Acquired on the Phoenix ICON · infant wide-field retinal image · 1240x1240px
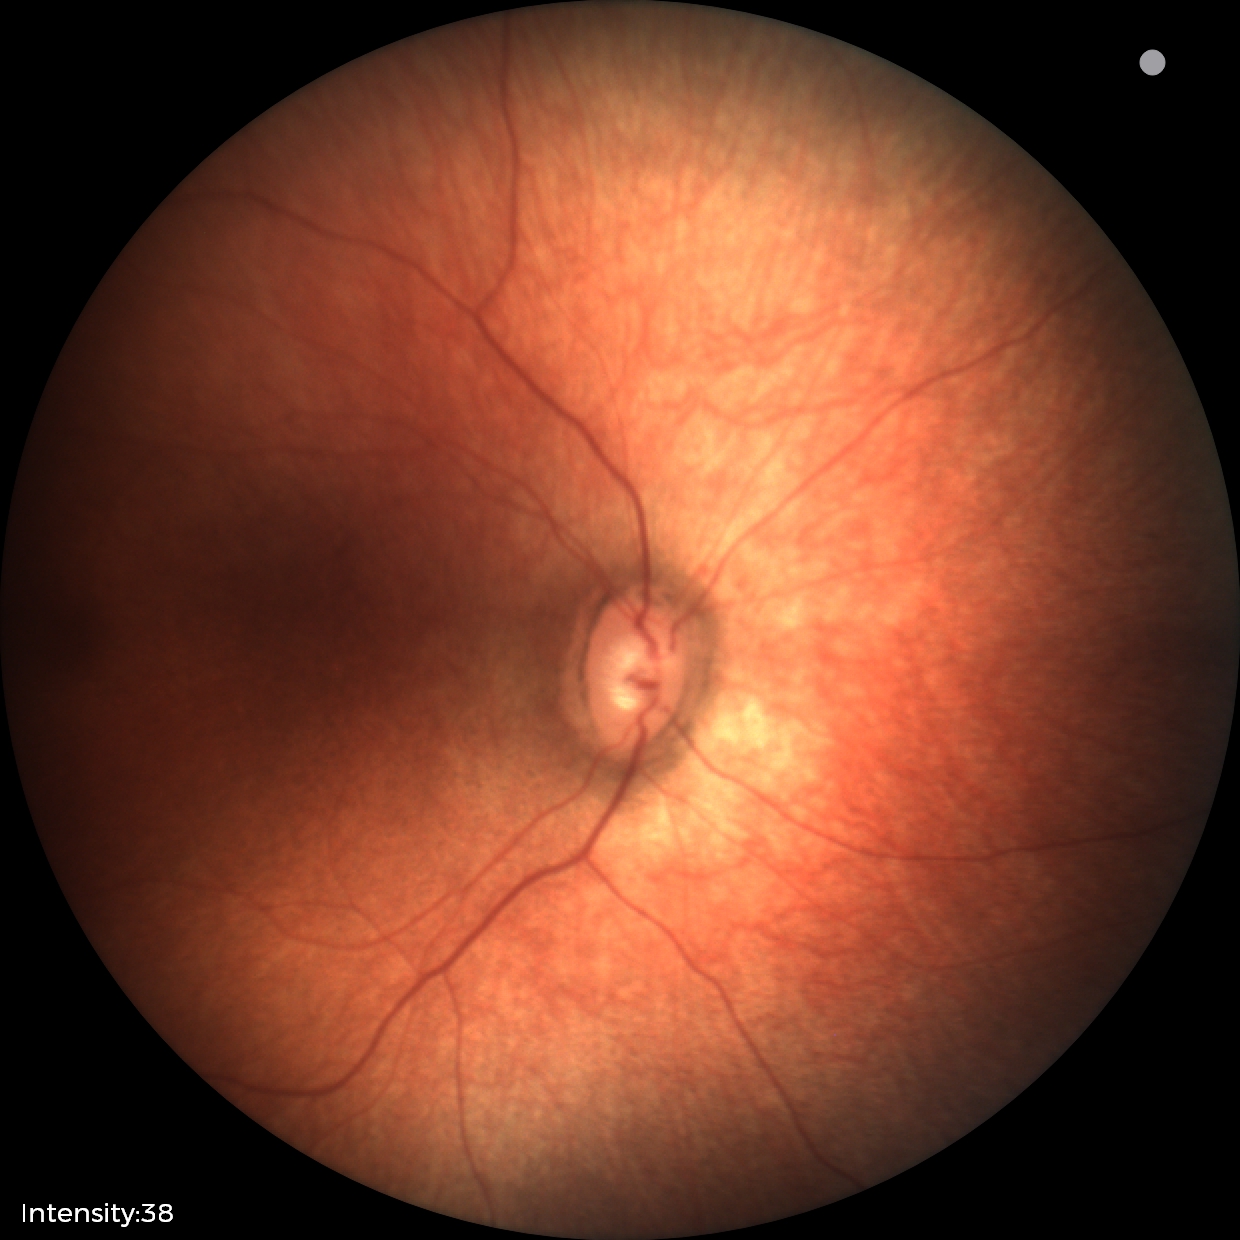 Q: What is the diagnosis from this examination?
A: no abnormal retinal findings